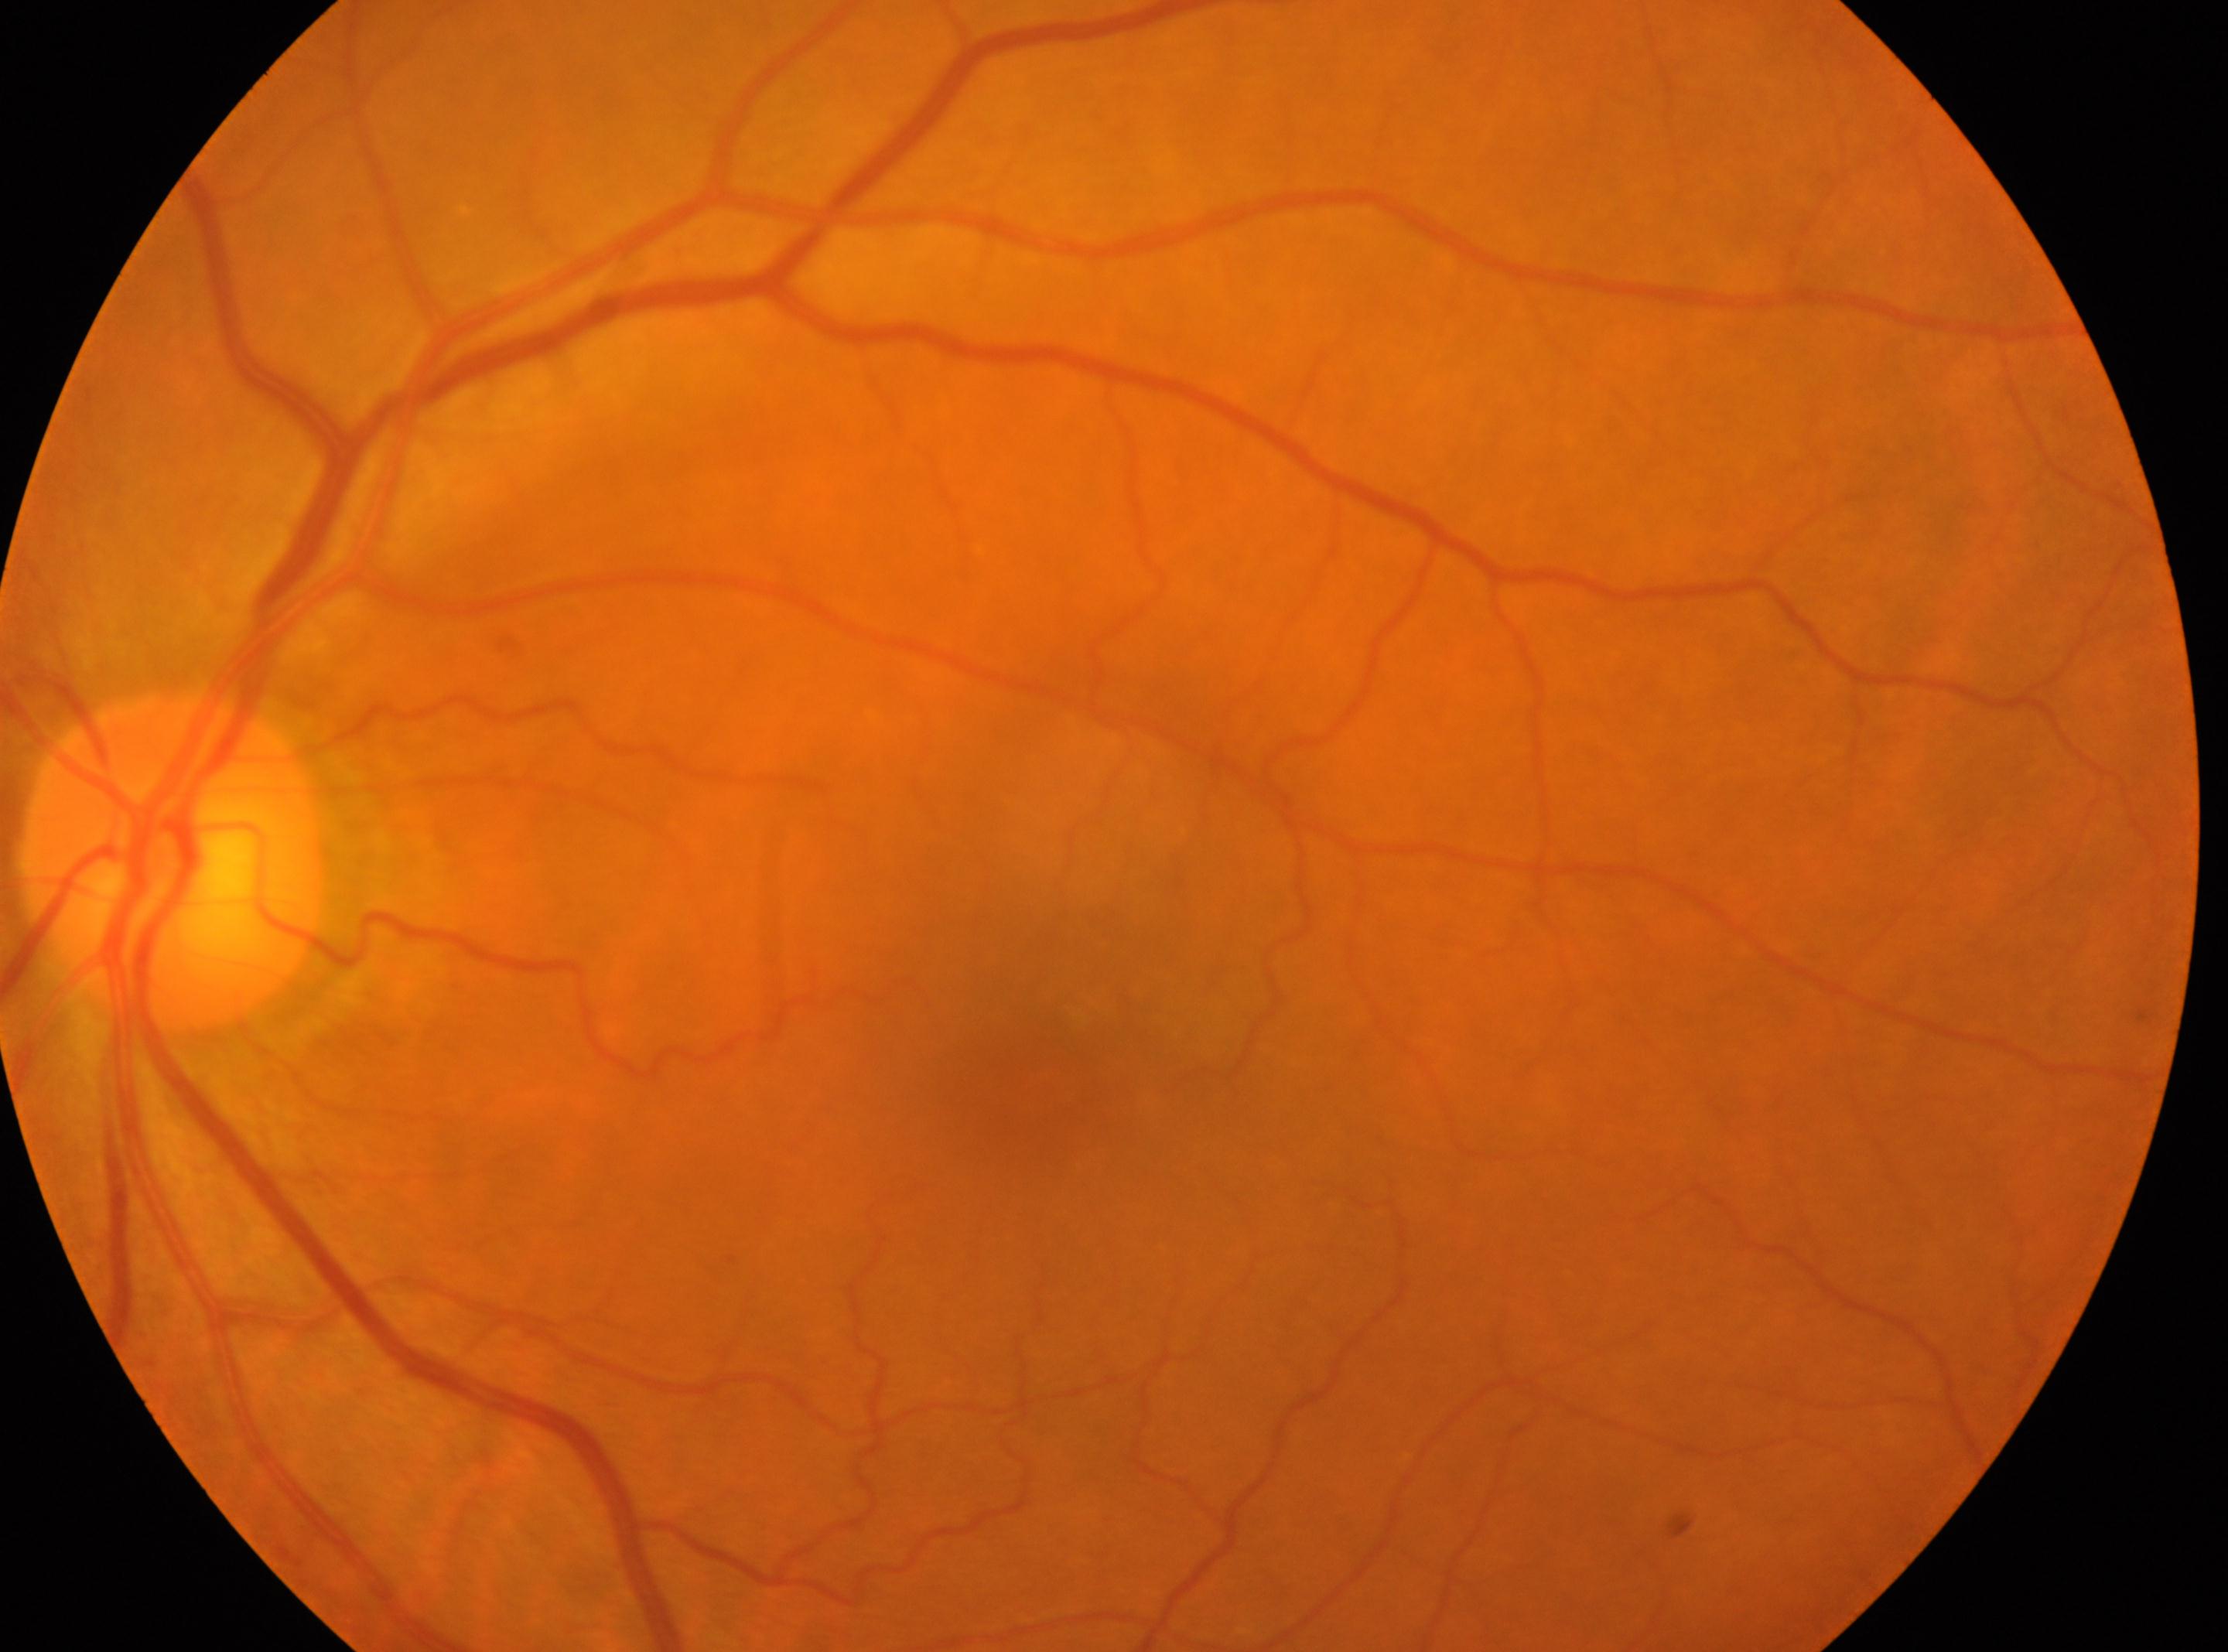 This is the OS.
DR stage is grade 0 (no apparent retinopathy).
Optic nerve head located at x=171, y=864.
Fovea centralis: x=1044, y=1078.